Acquired on the Clarity RetCam 3. Pediatric wide-field fundus photograph
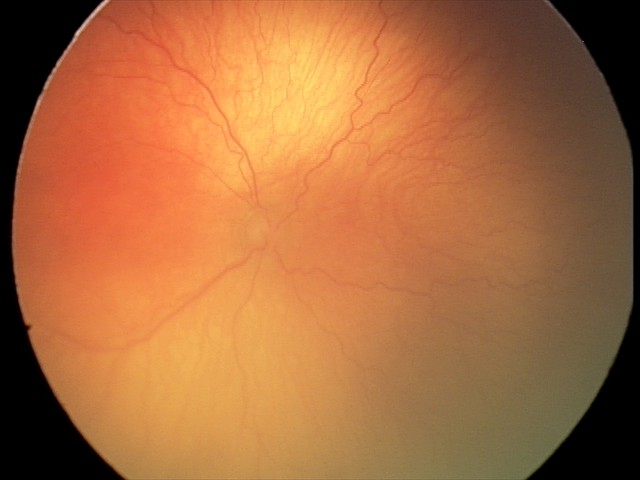

Series diagnosed as aggressive retinopathy of prematurity.